Infant wide-field fundus photograph: 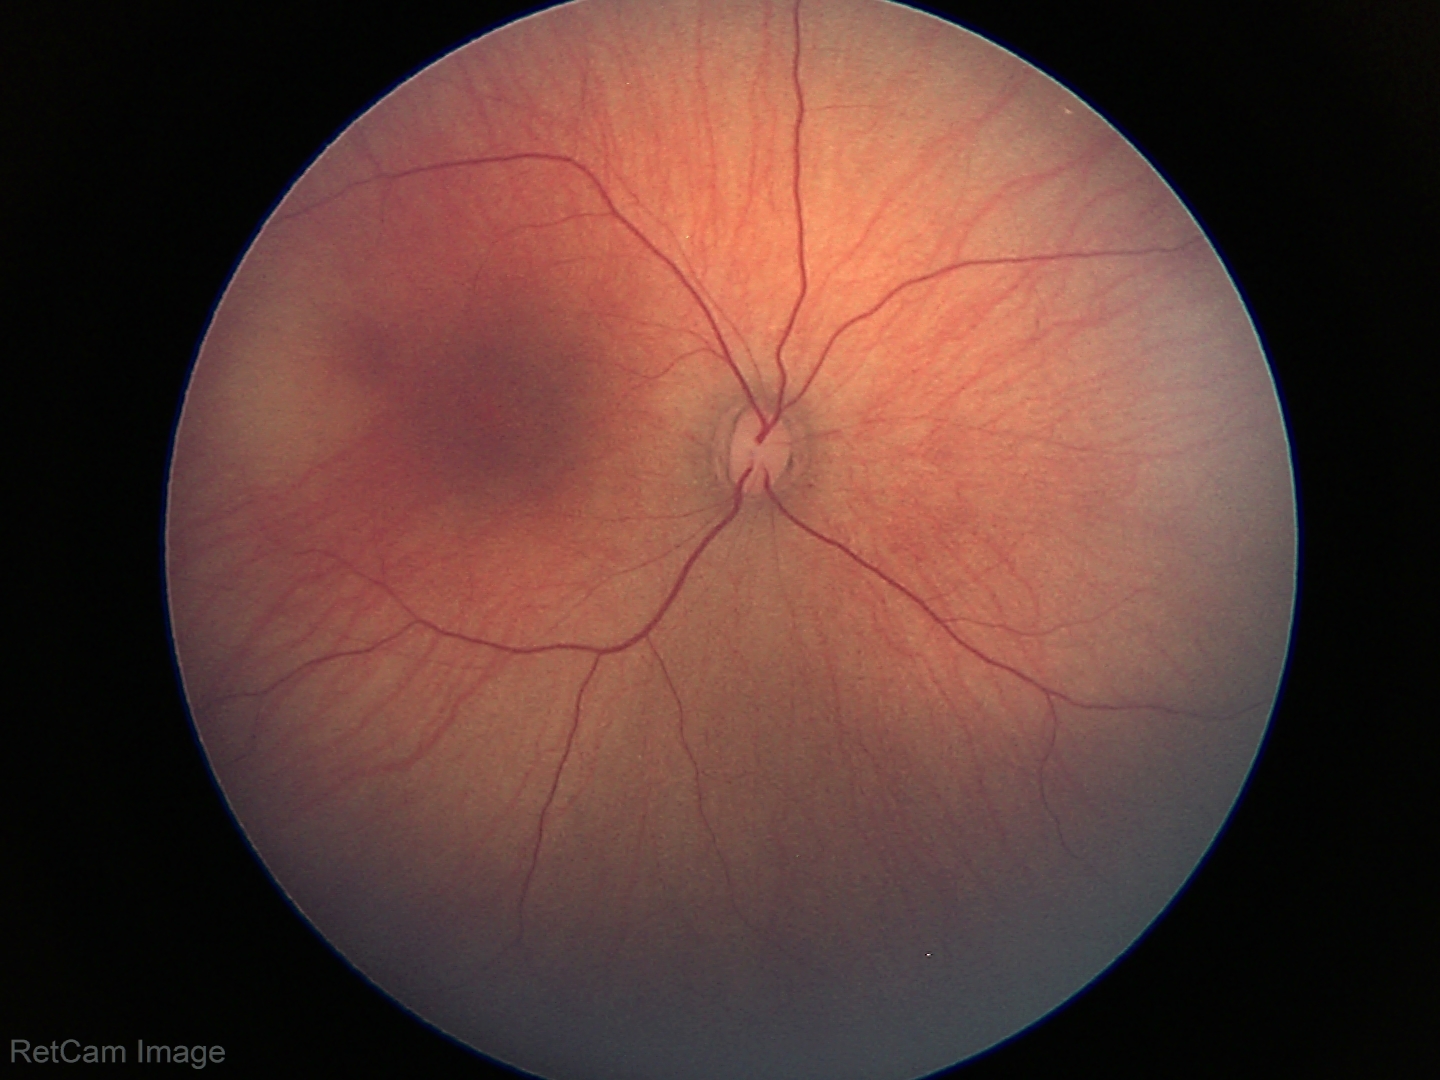
Q: What is the screening diagnosis?
A: no abnormal retinal findings